Infant wide-field fundus photograph; Clarity RetCam 3, 130° FOV — 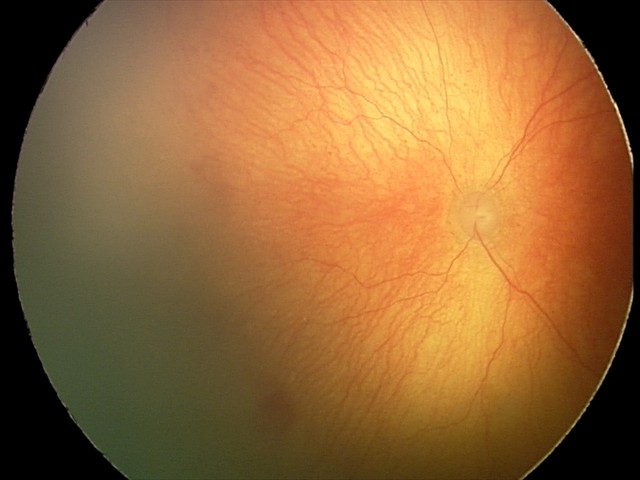

Screening series with aggressive retinopathy of prematurity (A-ROP).